848x848
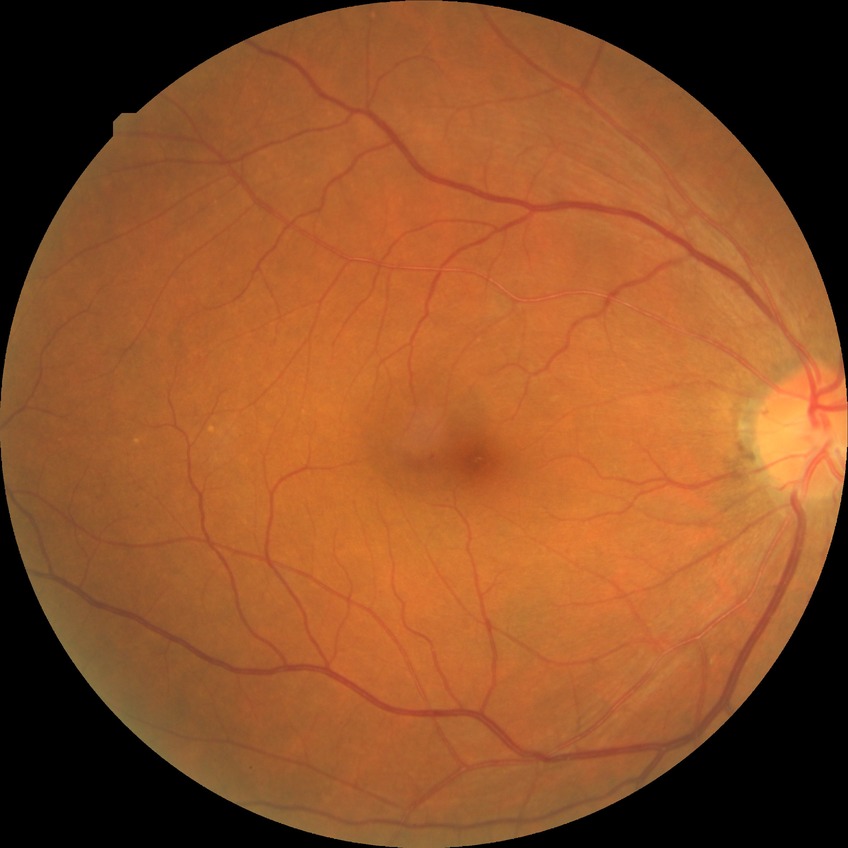
DR class: non-proliferative diabetic retinopathy | diabetic retinopathy stage: simple diabetic retinopathy.